Fundus photo · 45-degree field of view · image size 2212x1659.
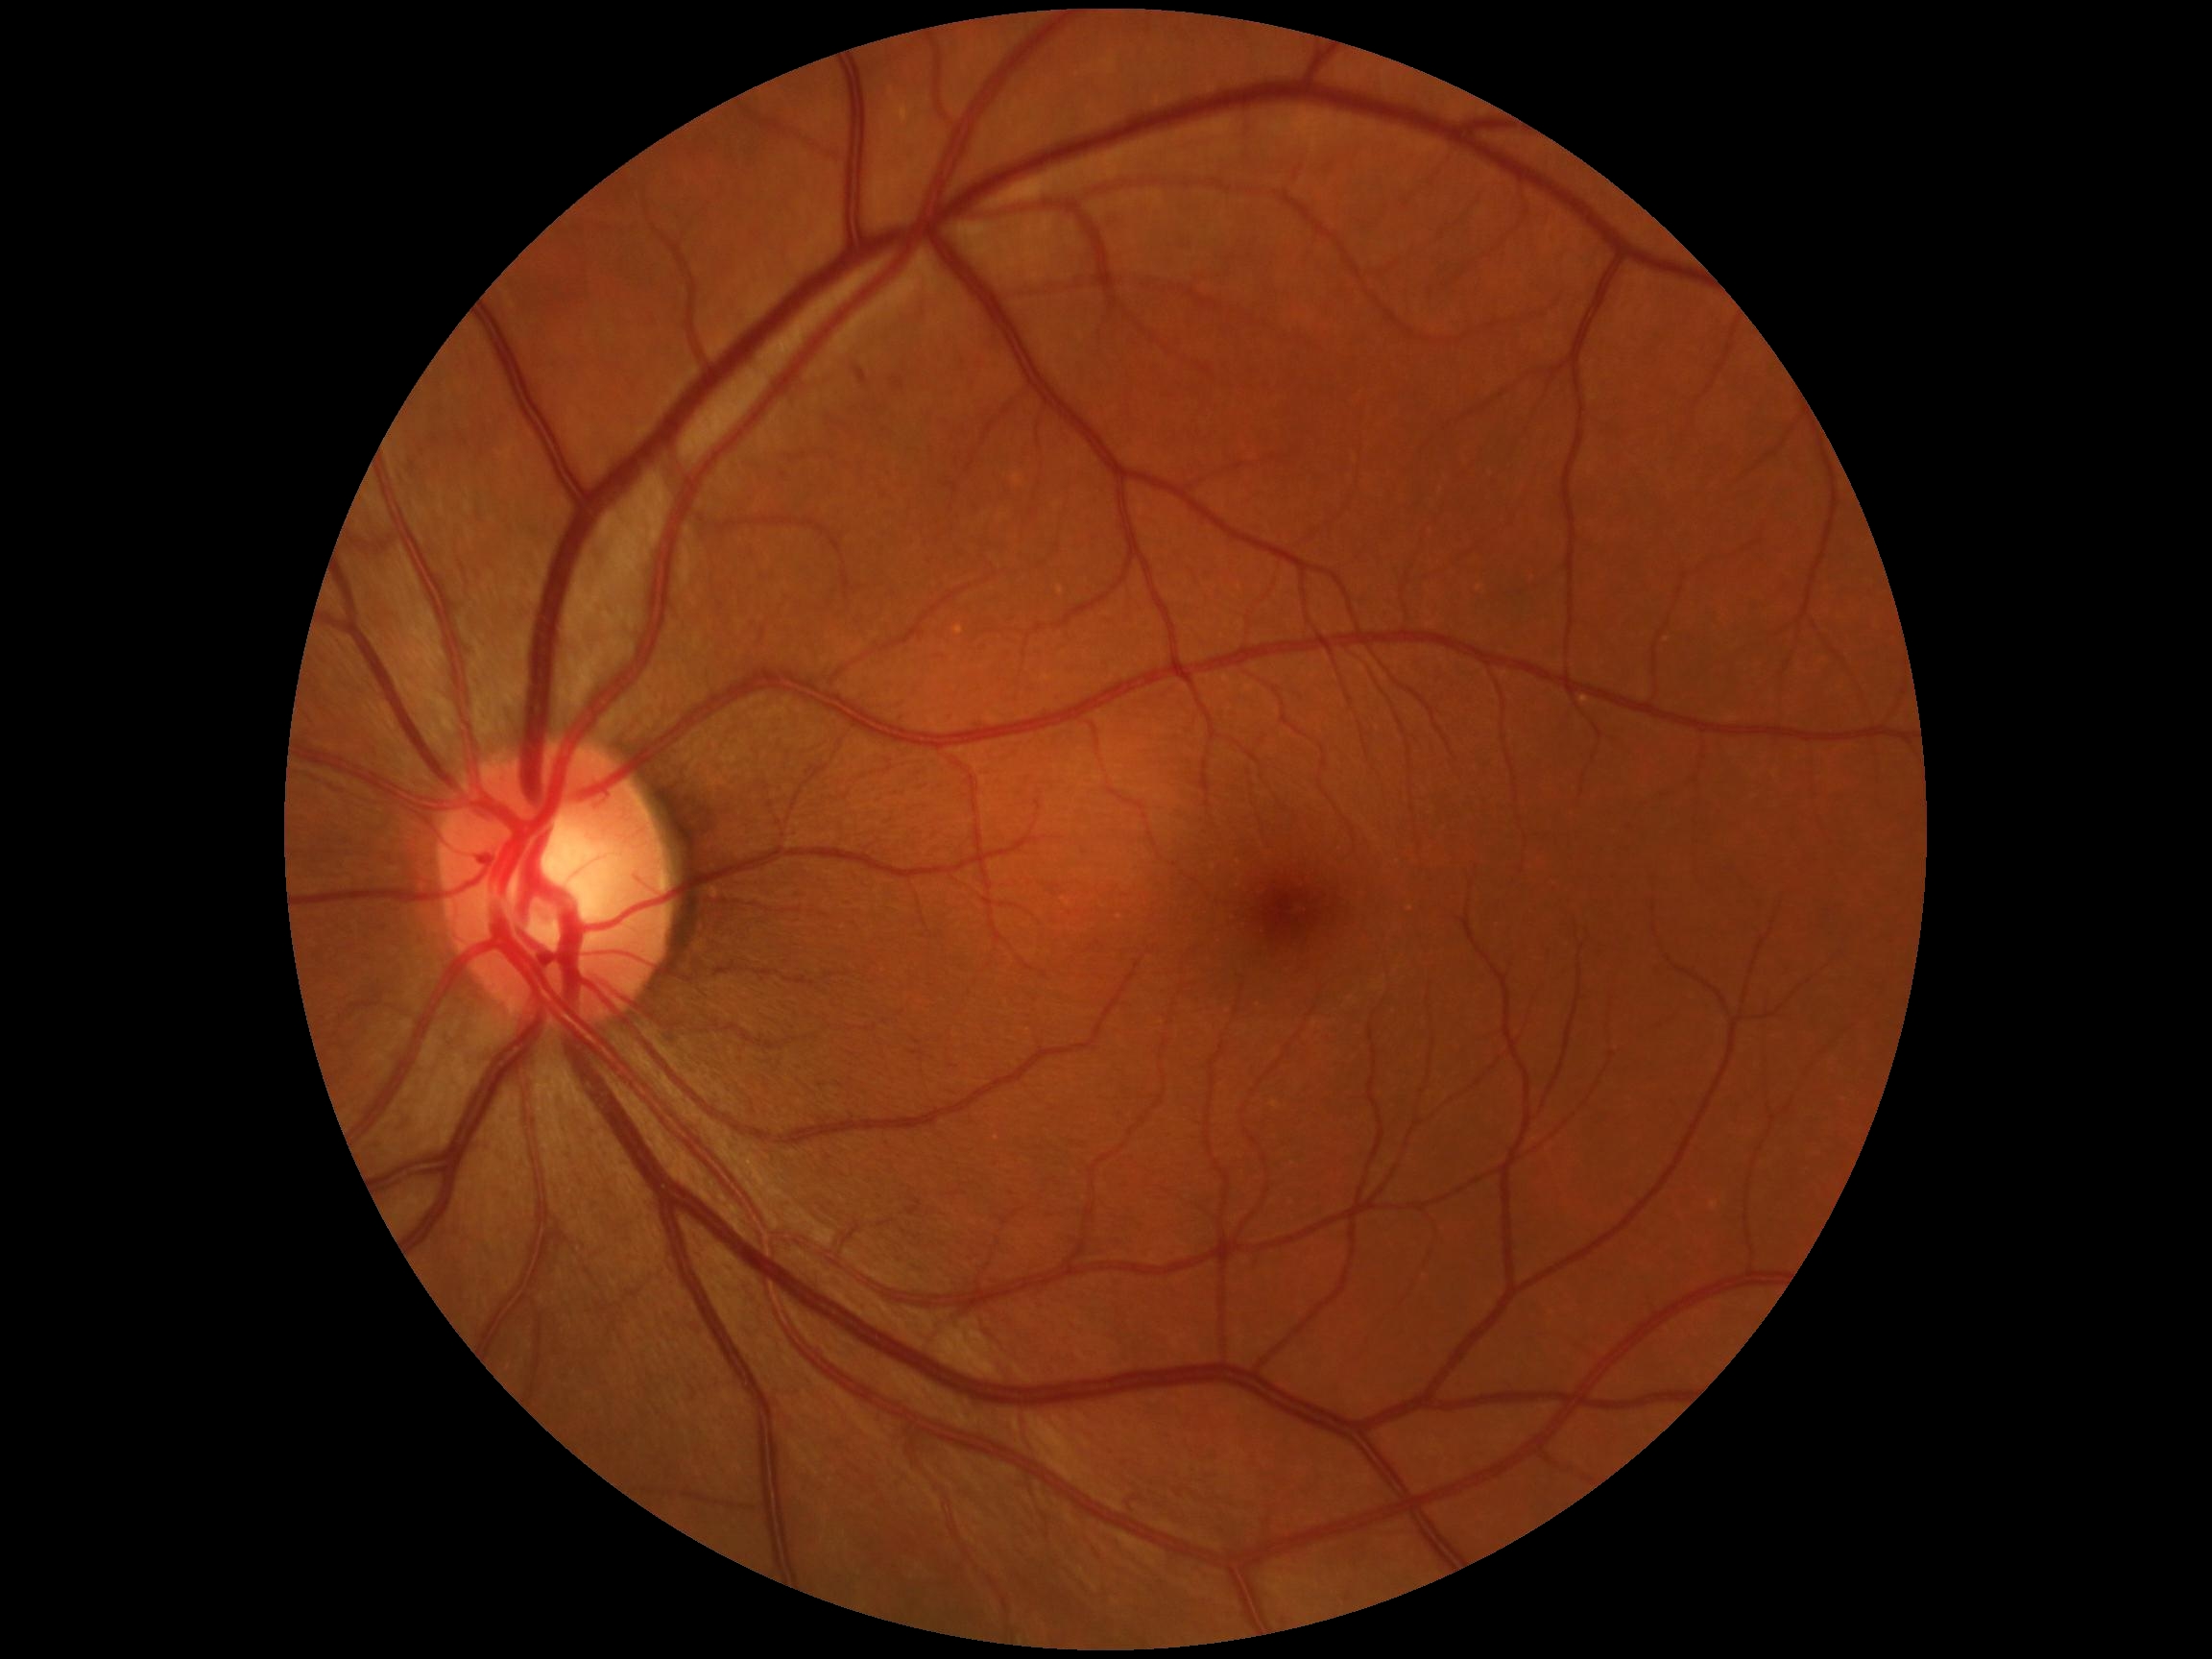 DR: moderate non-proliferative diabetic retinopathy (grade 2).